45-degree field of view:
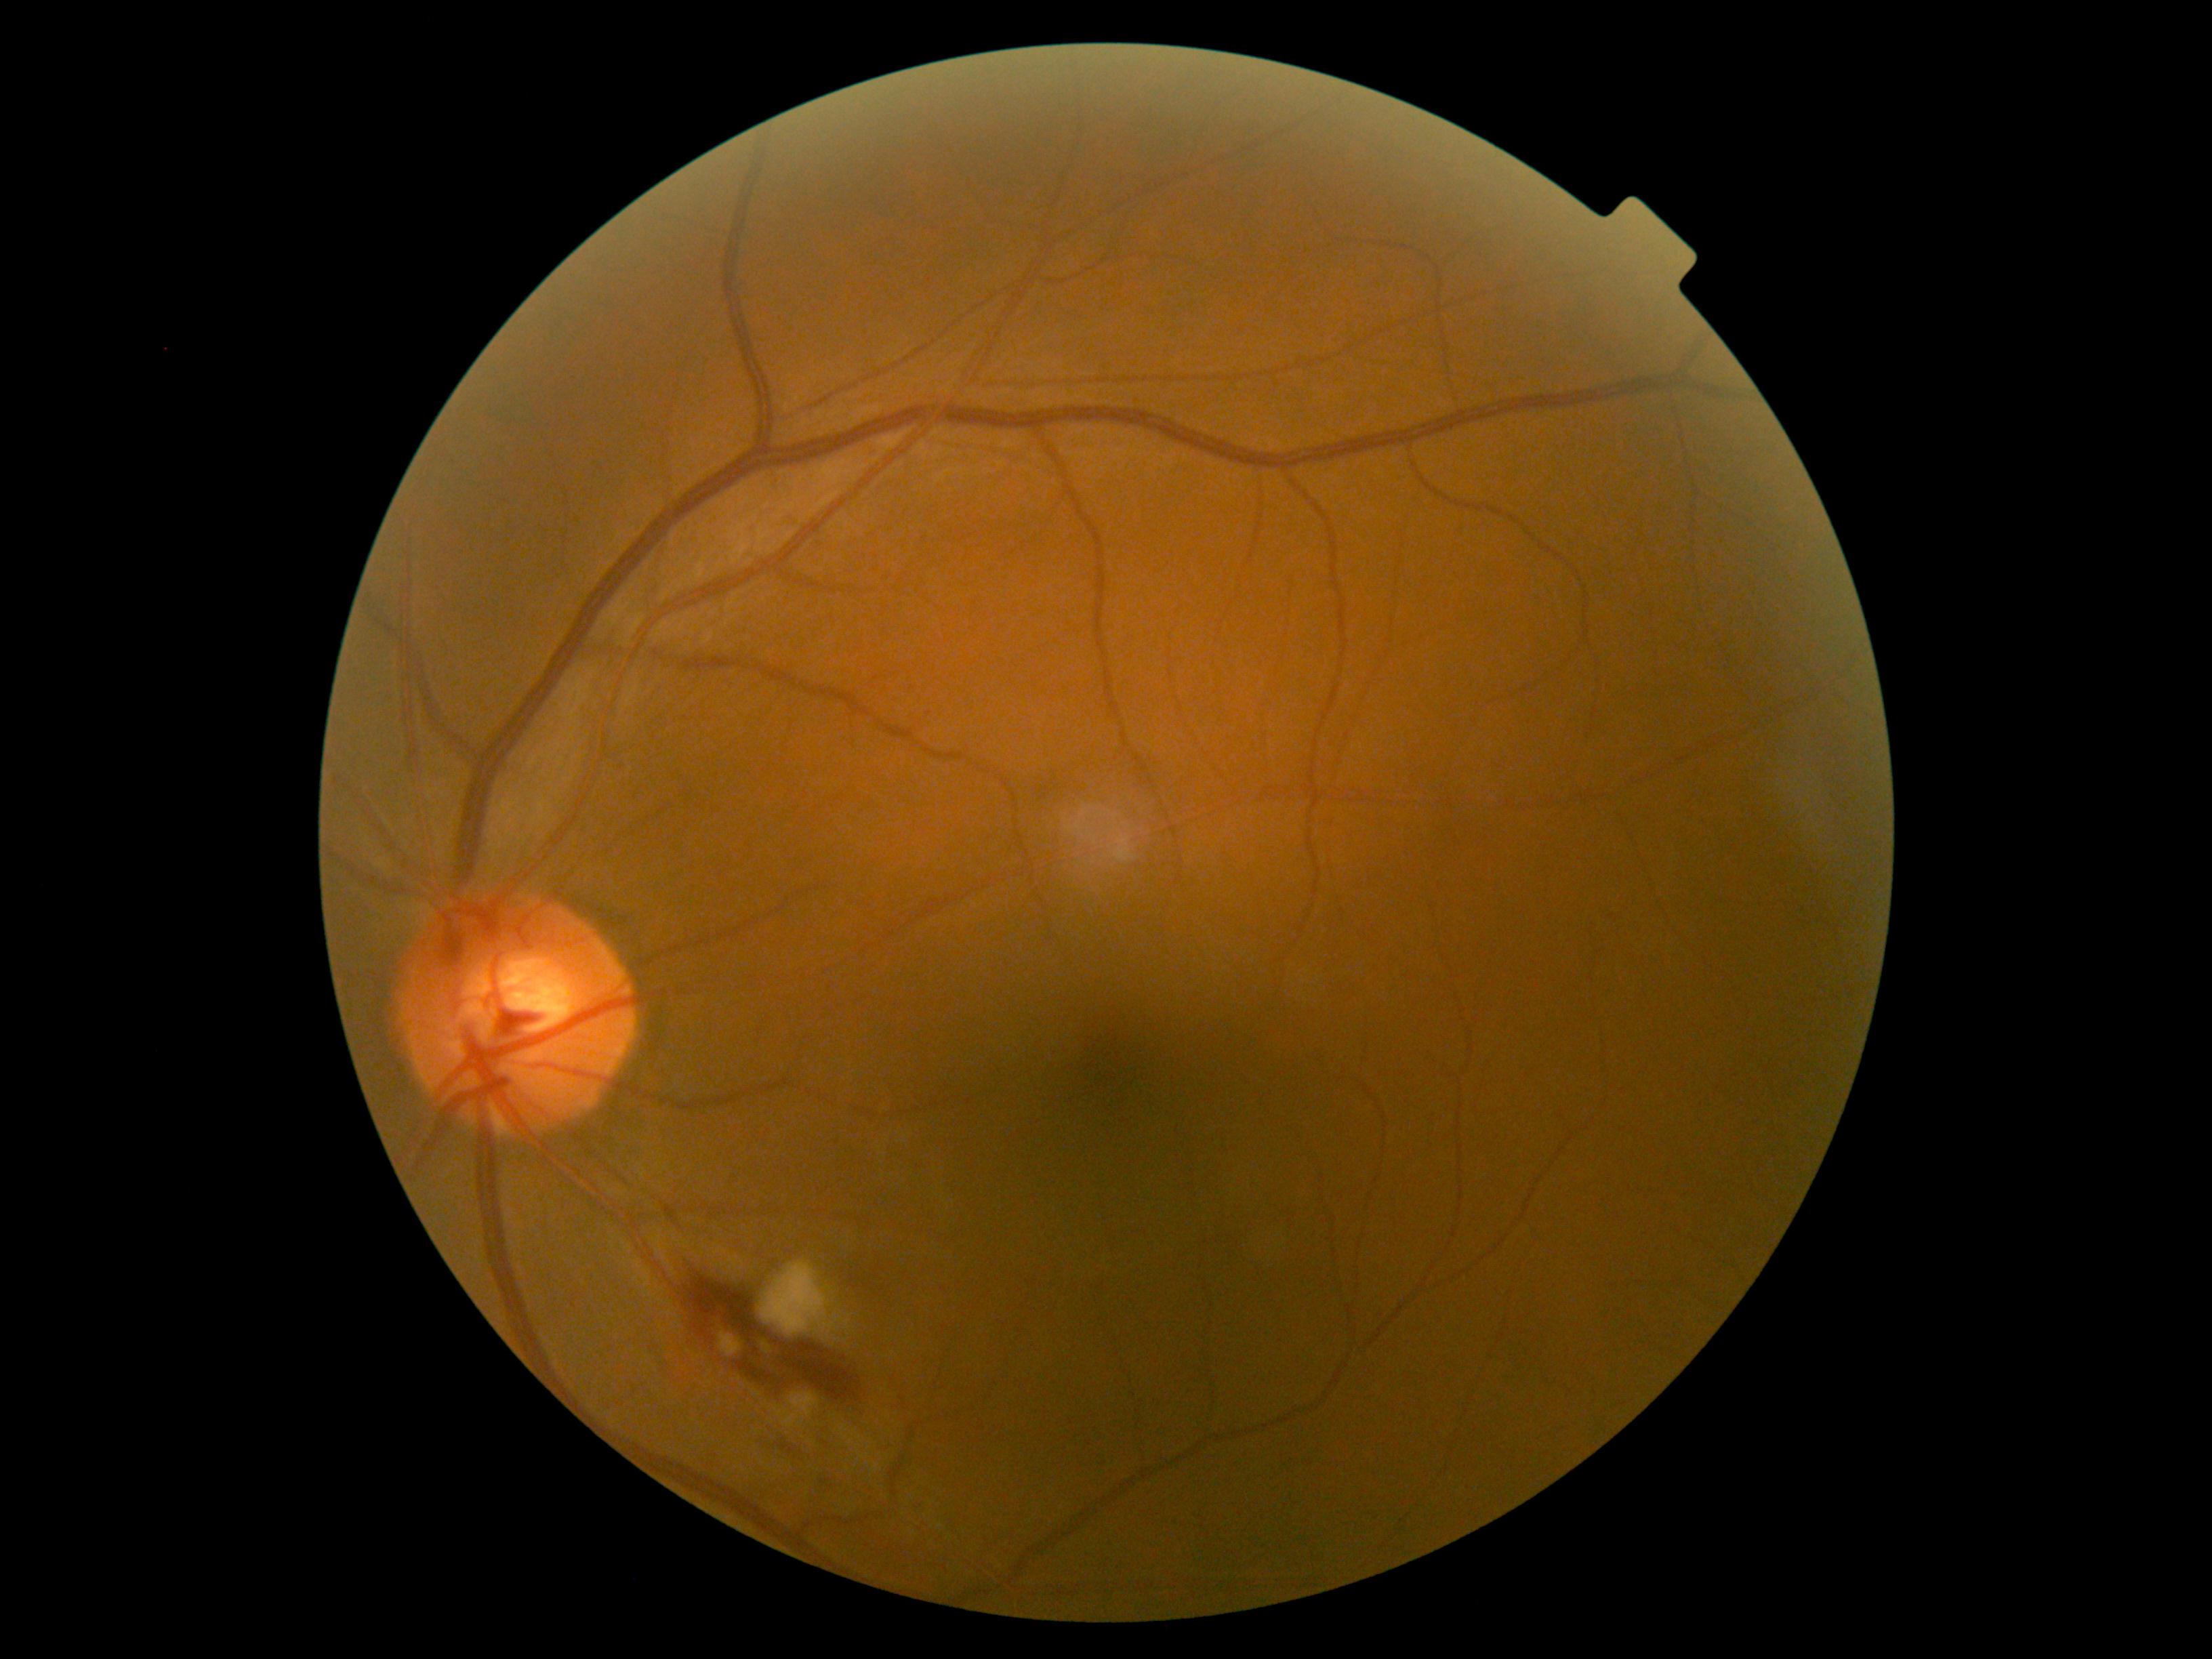
retinopathy: grade 2.